45° field of view · color fundus image — 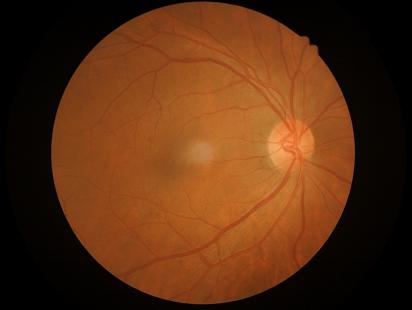 Overall quality is good and the image is gradable. Optic disc, vessels, and background are in focus. Even illumination with no color cast.